Fundus photo, 1504x1000:
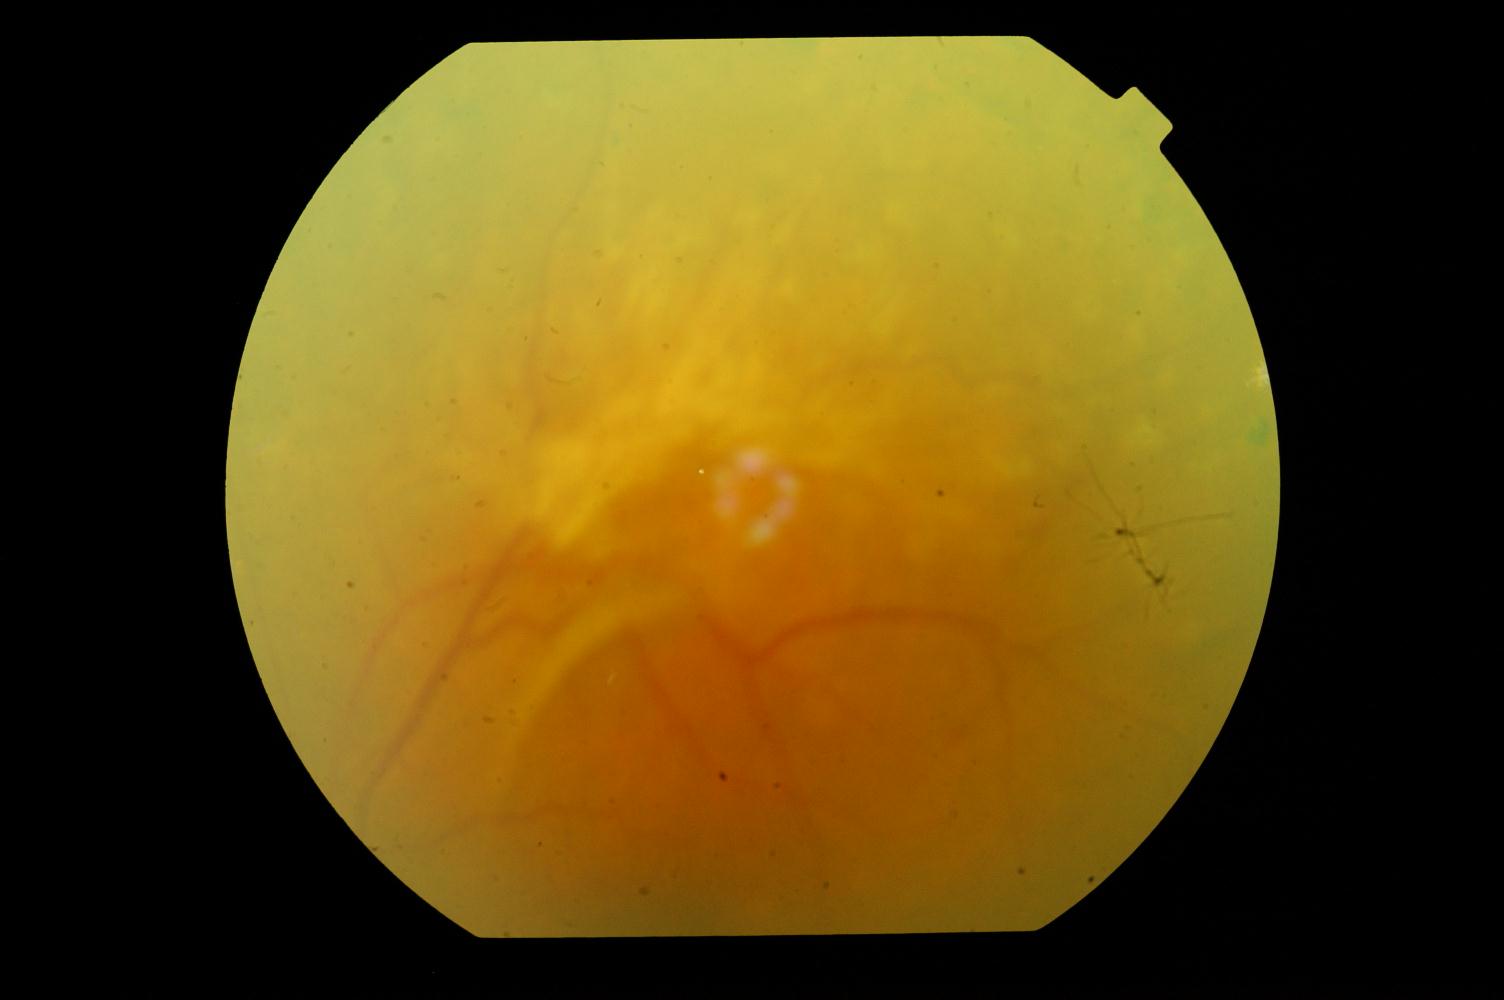 Showing diabetic retinopathy (DR).